200° FOV. Ultra-widefield fundus photograph: 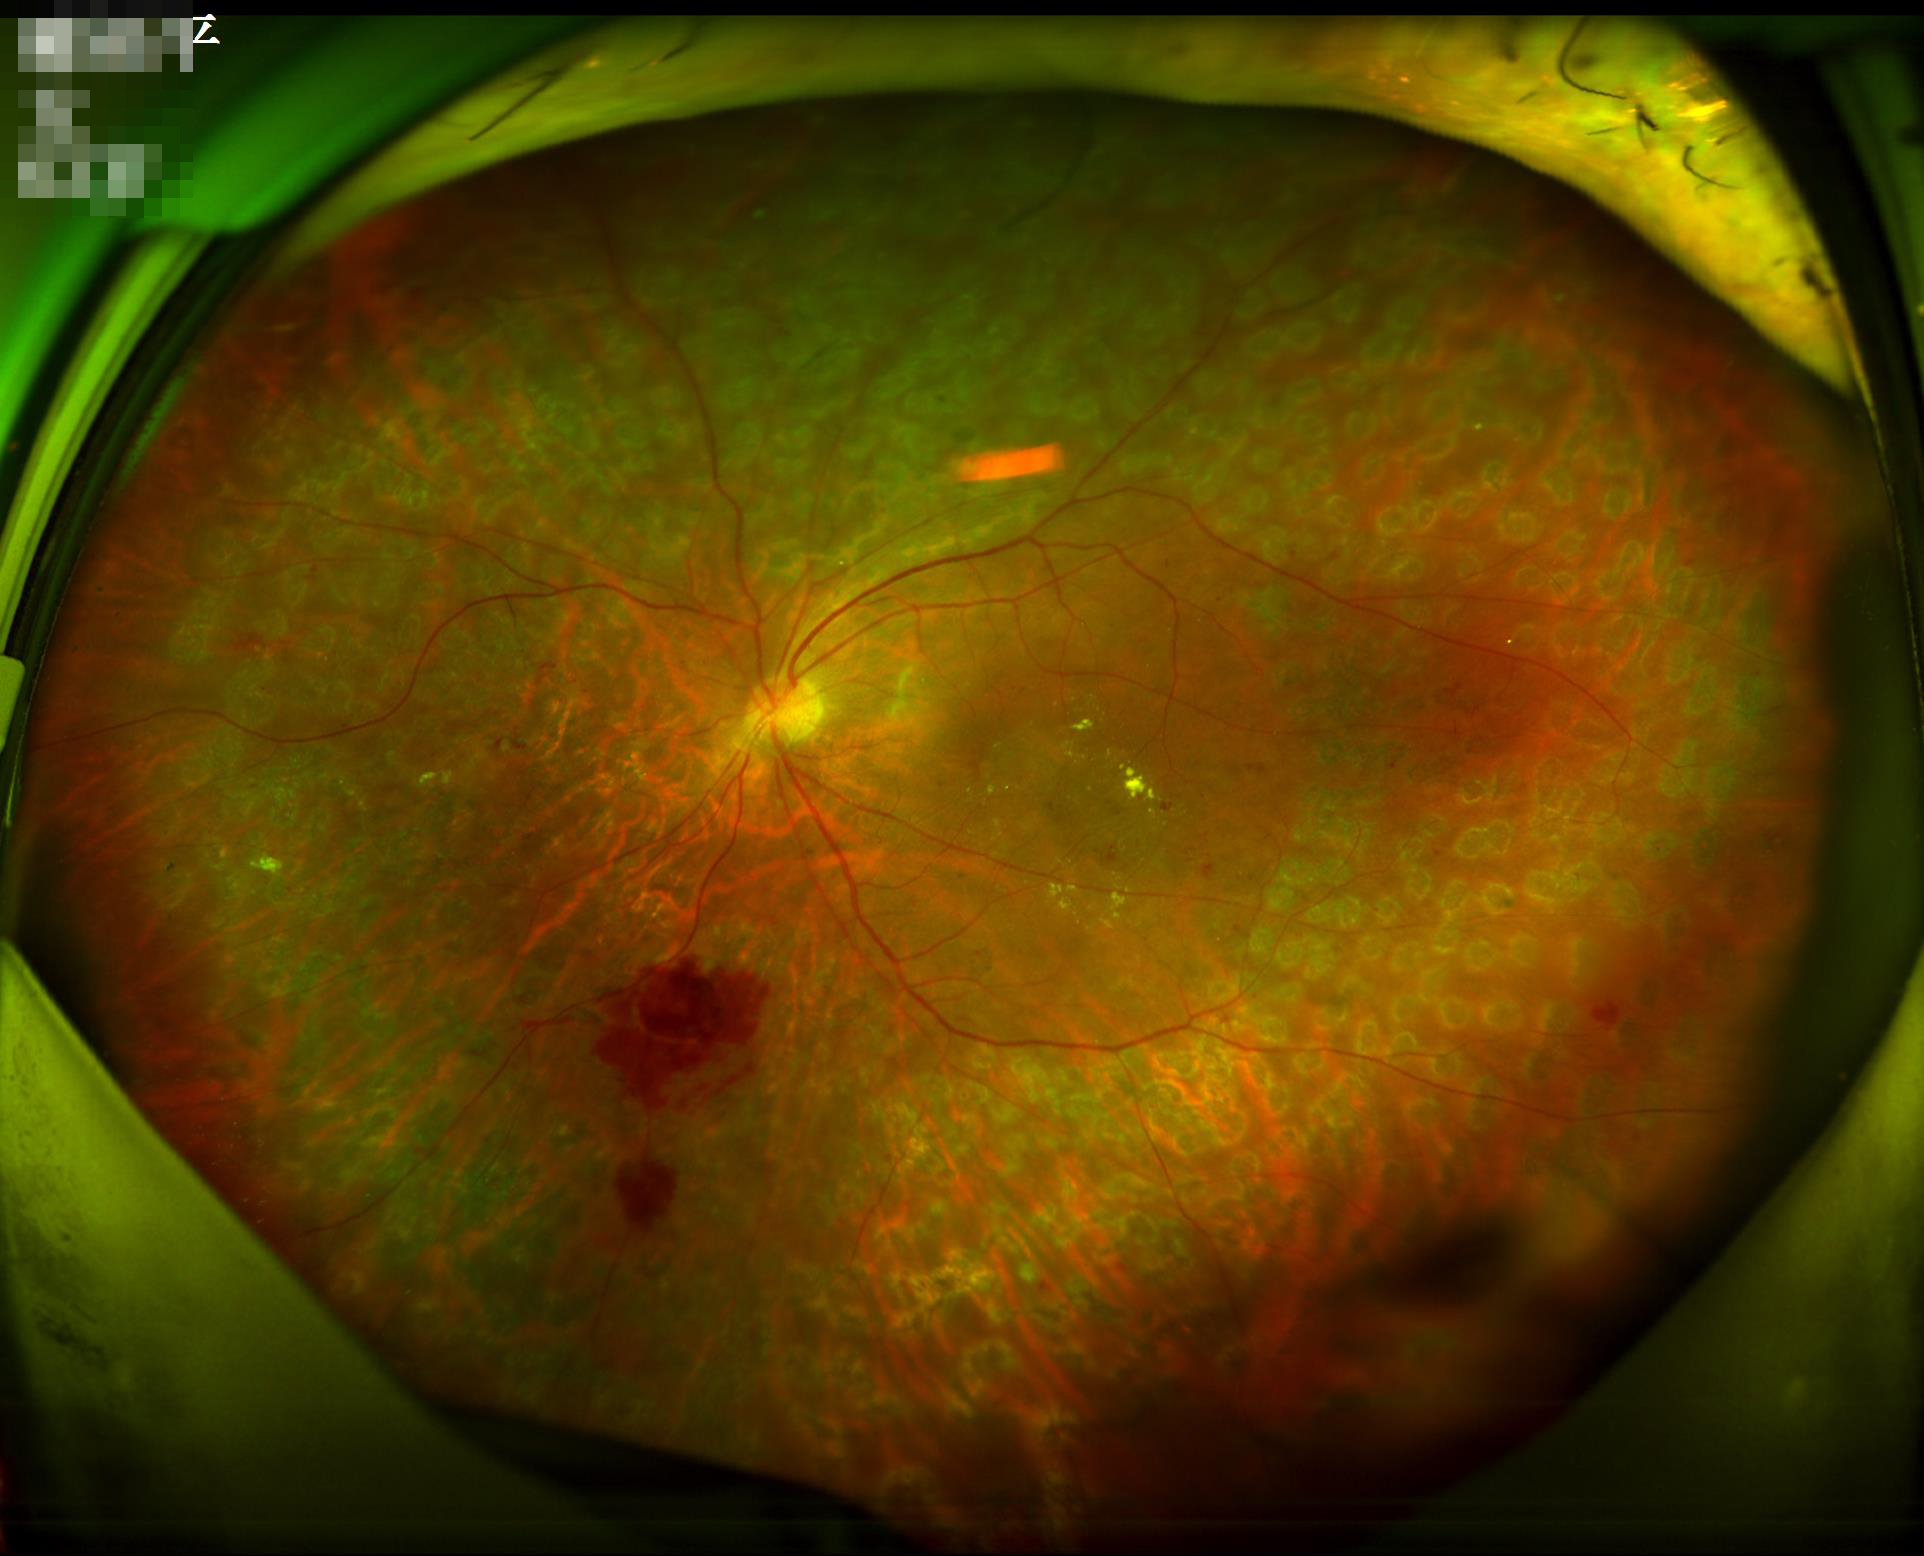
Even illumination with no color cast. Optic disc, vessels, and background are in focus. Adequate contrast for distinguishing structures. Acceptable image quality.